NIDEK AFC-230, modified Davis grading: 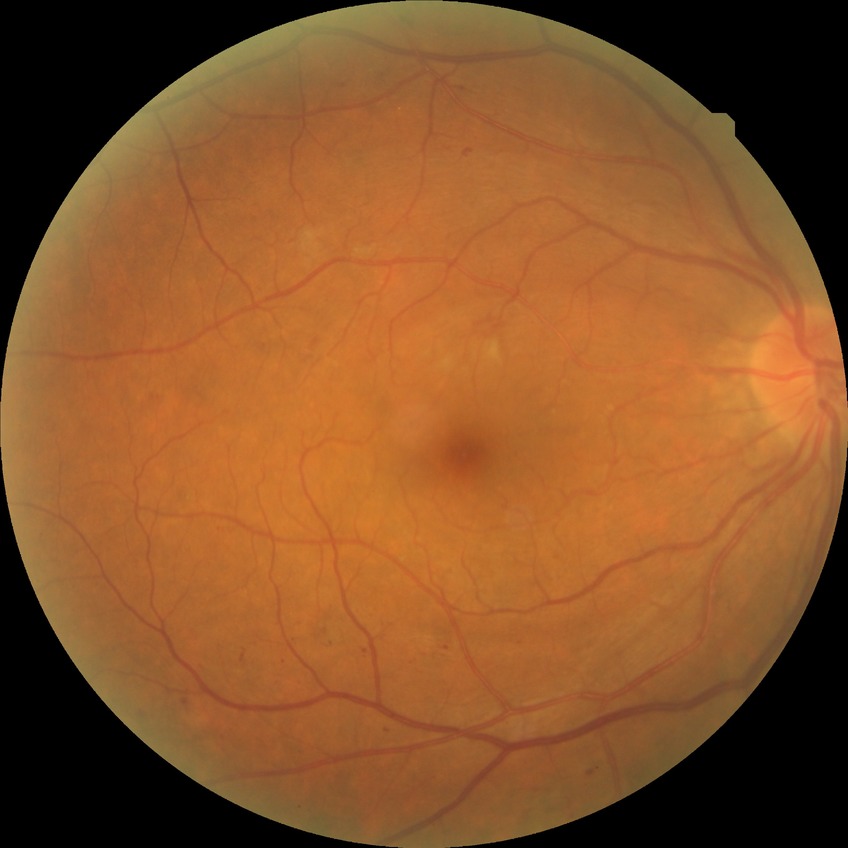
diabetic retinopathy (DR): simple diabetic retinopathy (SDR)